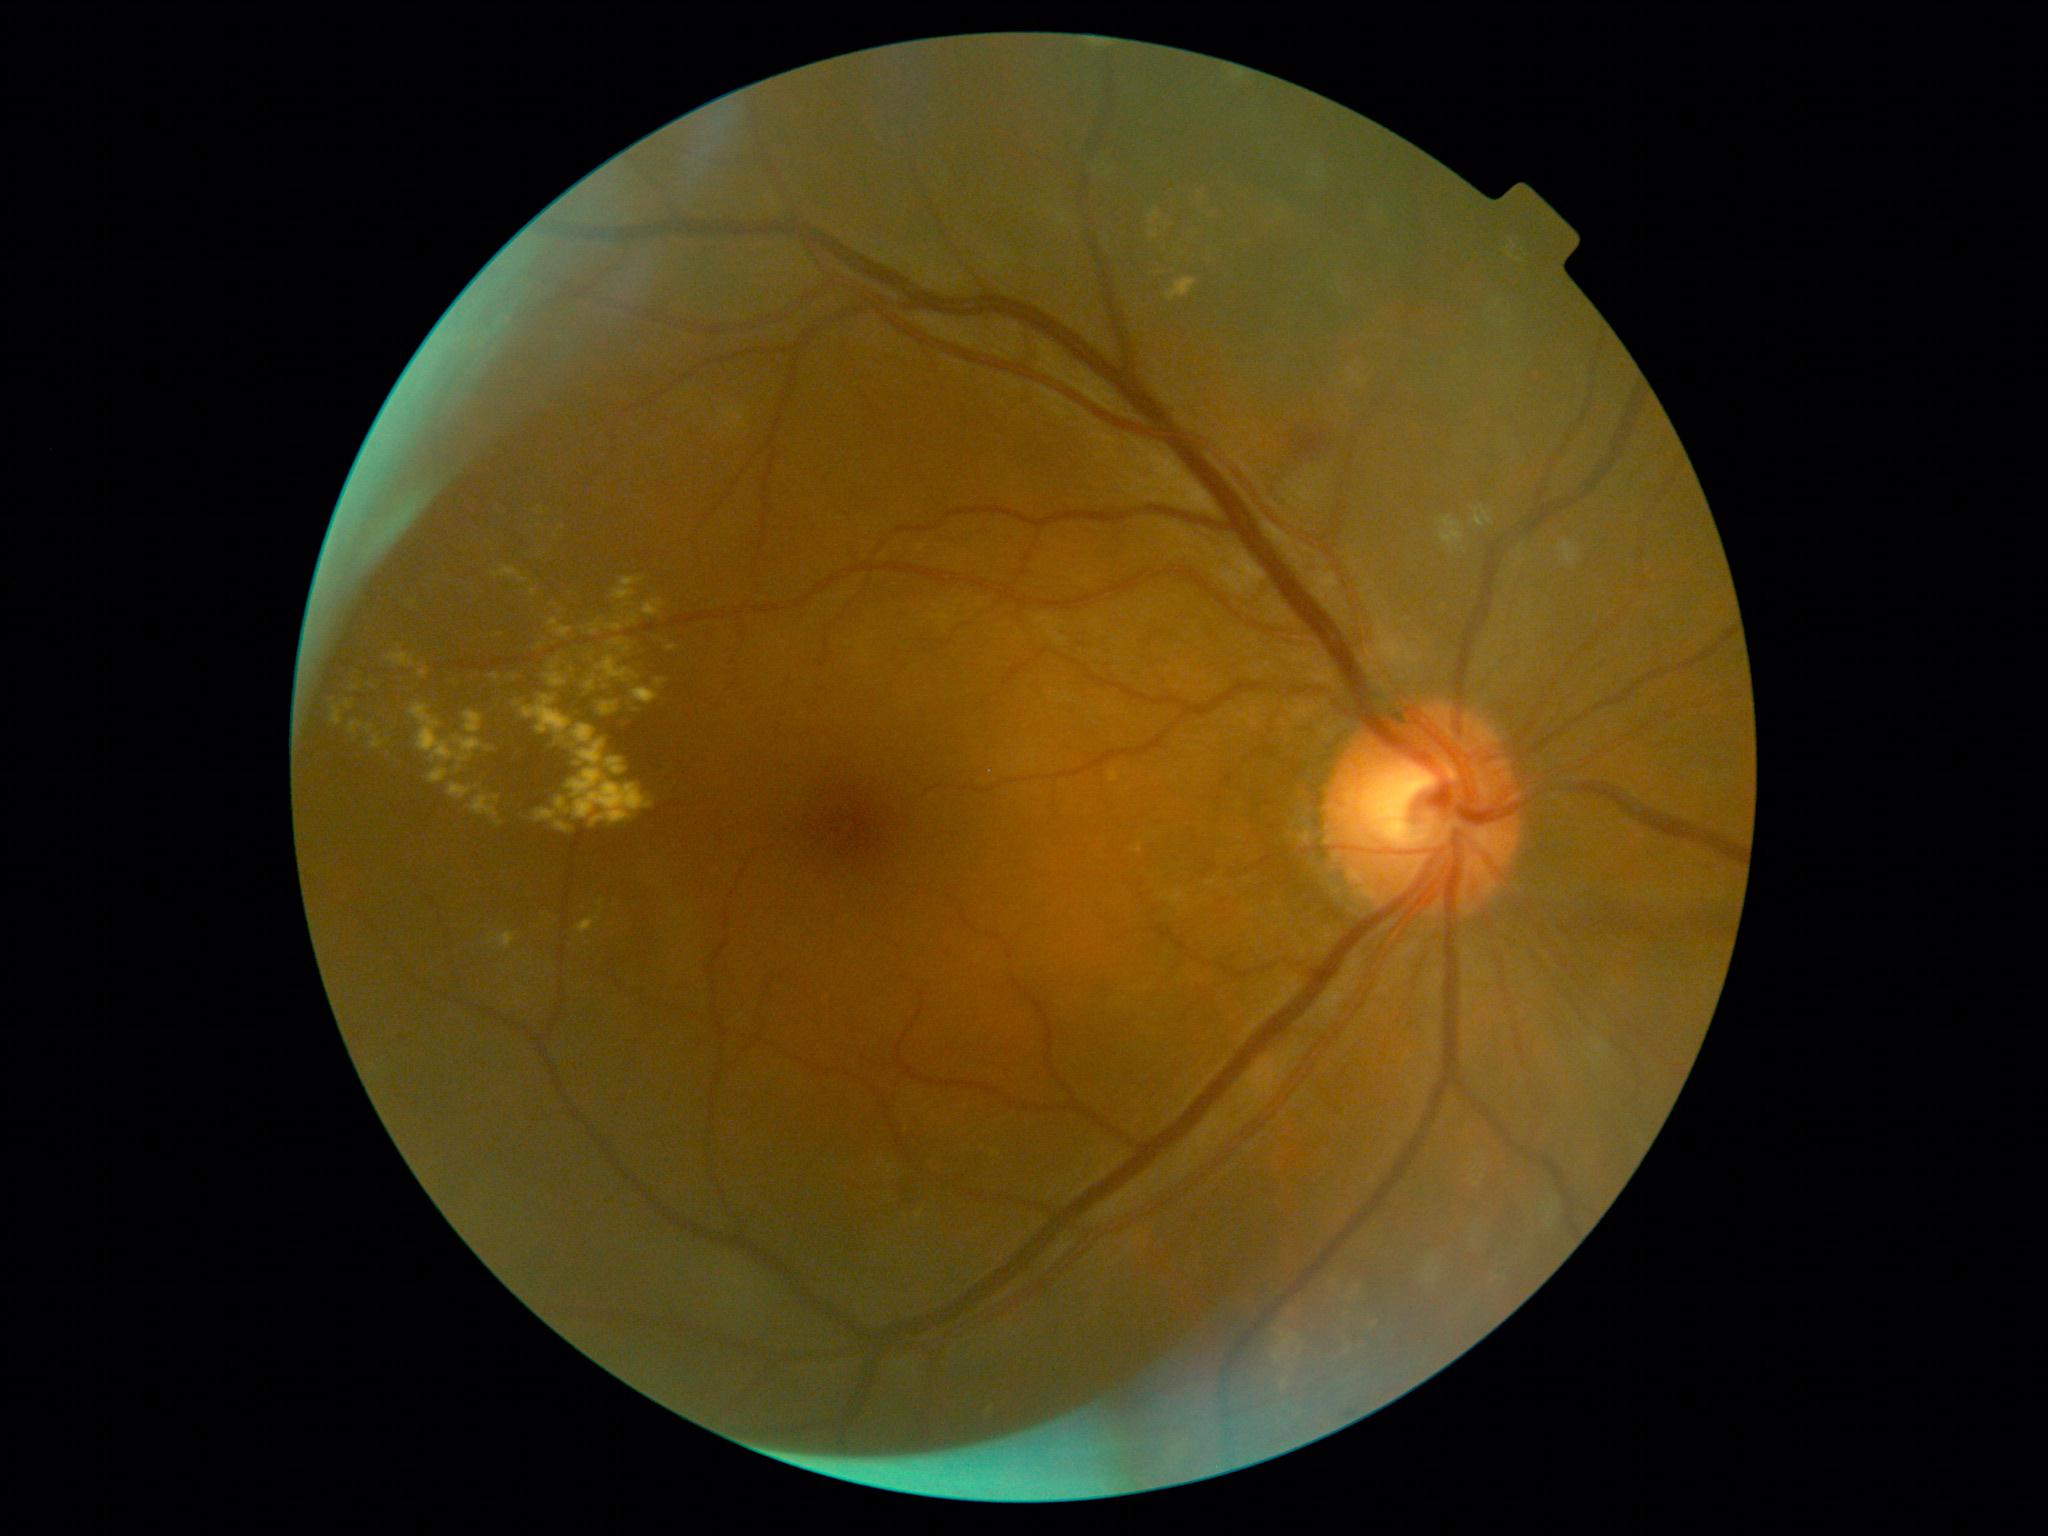
partial: true
dr_grade: 2
dr_grade_name: moderate NPDR
lesions:
  ex:
    - bbox=[489, 932, 517, 950]
    - bbox=[464, 711, 483, 734]
    - bbox=[1167, 278, 1197, 302]
    - bbox=[410, 703, 496, 762]
    - bbox=[418, 669, 428, 679]
    - bbox=[1194, 184, 1227, 218]
    - bbox=[345, 701, 352, 710]
    - bbox=[1368, 1318, 1376, 1329]
    - bbox=[591, 620, 599, 635]
    - bbox=[618, 716, 635, 726]
    - bbox=[530, 589, 536, 597]
    - bbox=[496, 633, 504, 637]
    - bbox=[627, 633, 644, 670]
    - bbox=[1348, 1282, 1361, 1304]
    - bbox=[555, 821, 572, 833]
    - bbox=[606, 758, 628, 775]
  ex_small:
    - 637:710